CFP · captured after pupil dilation:
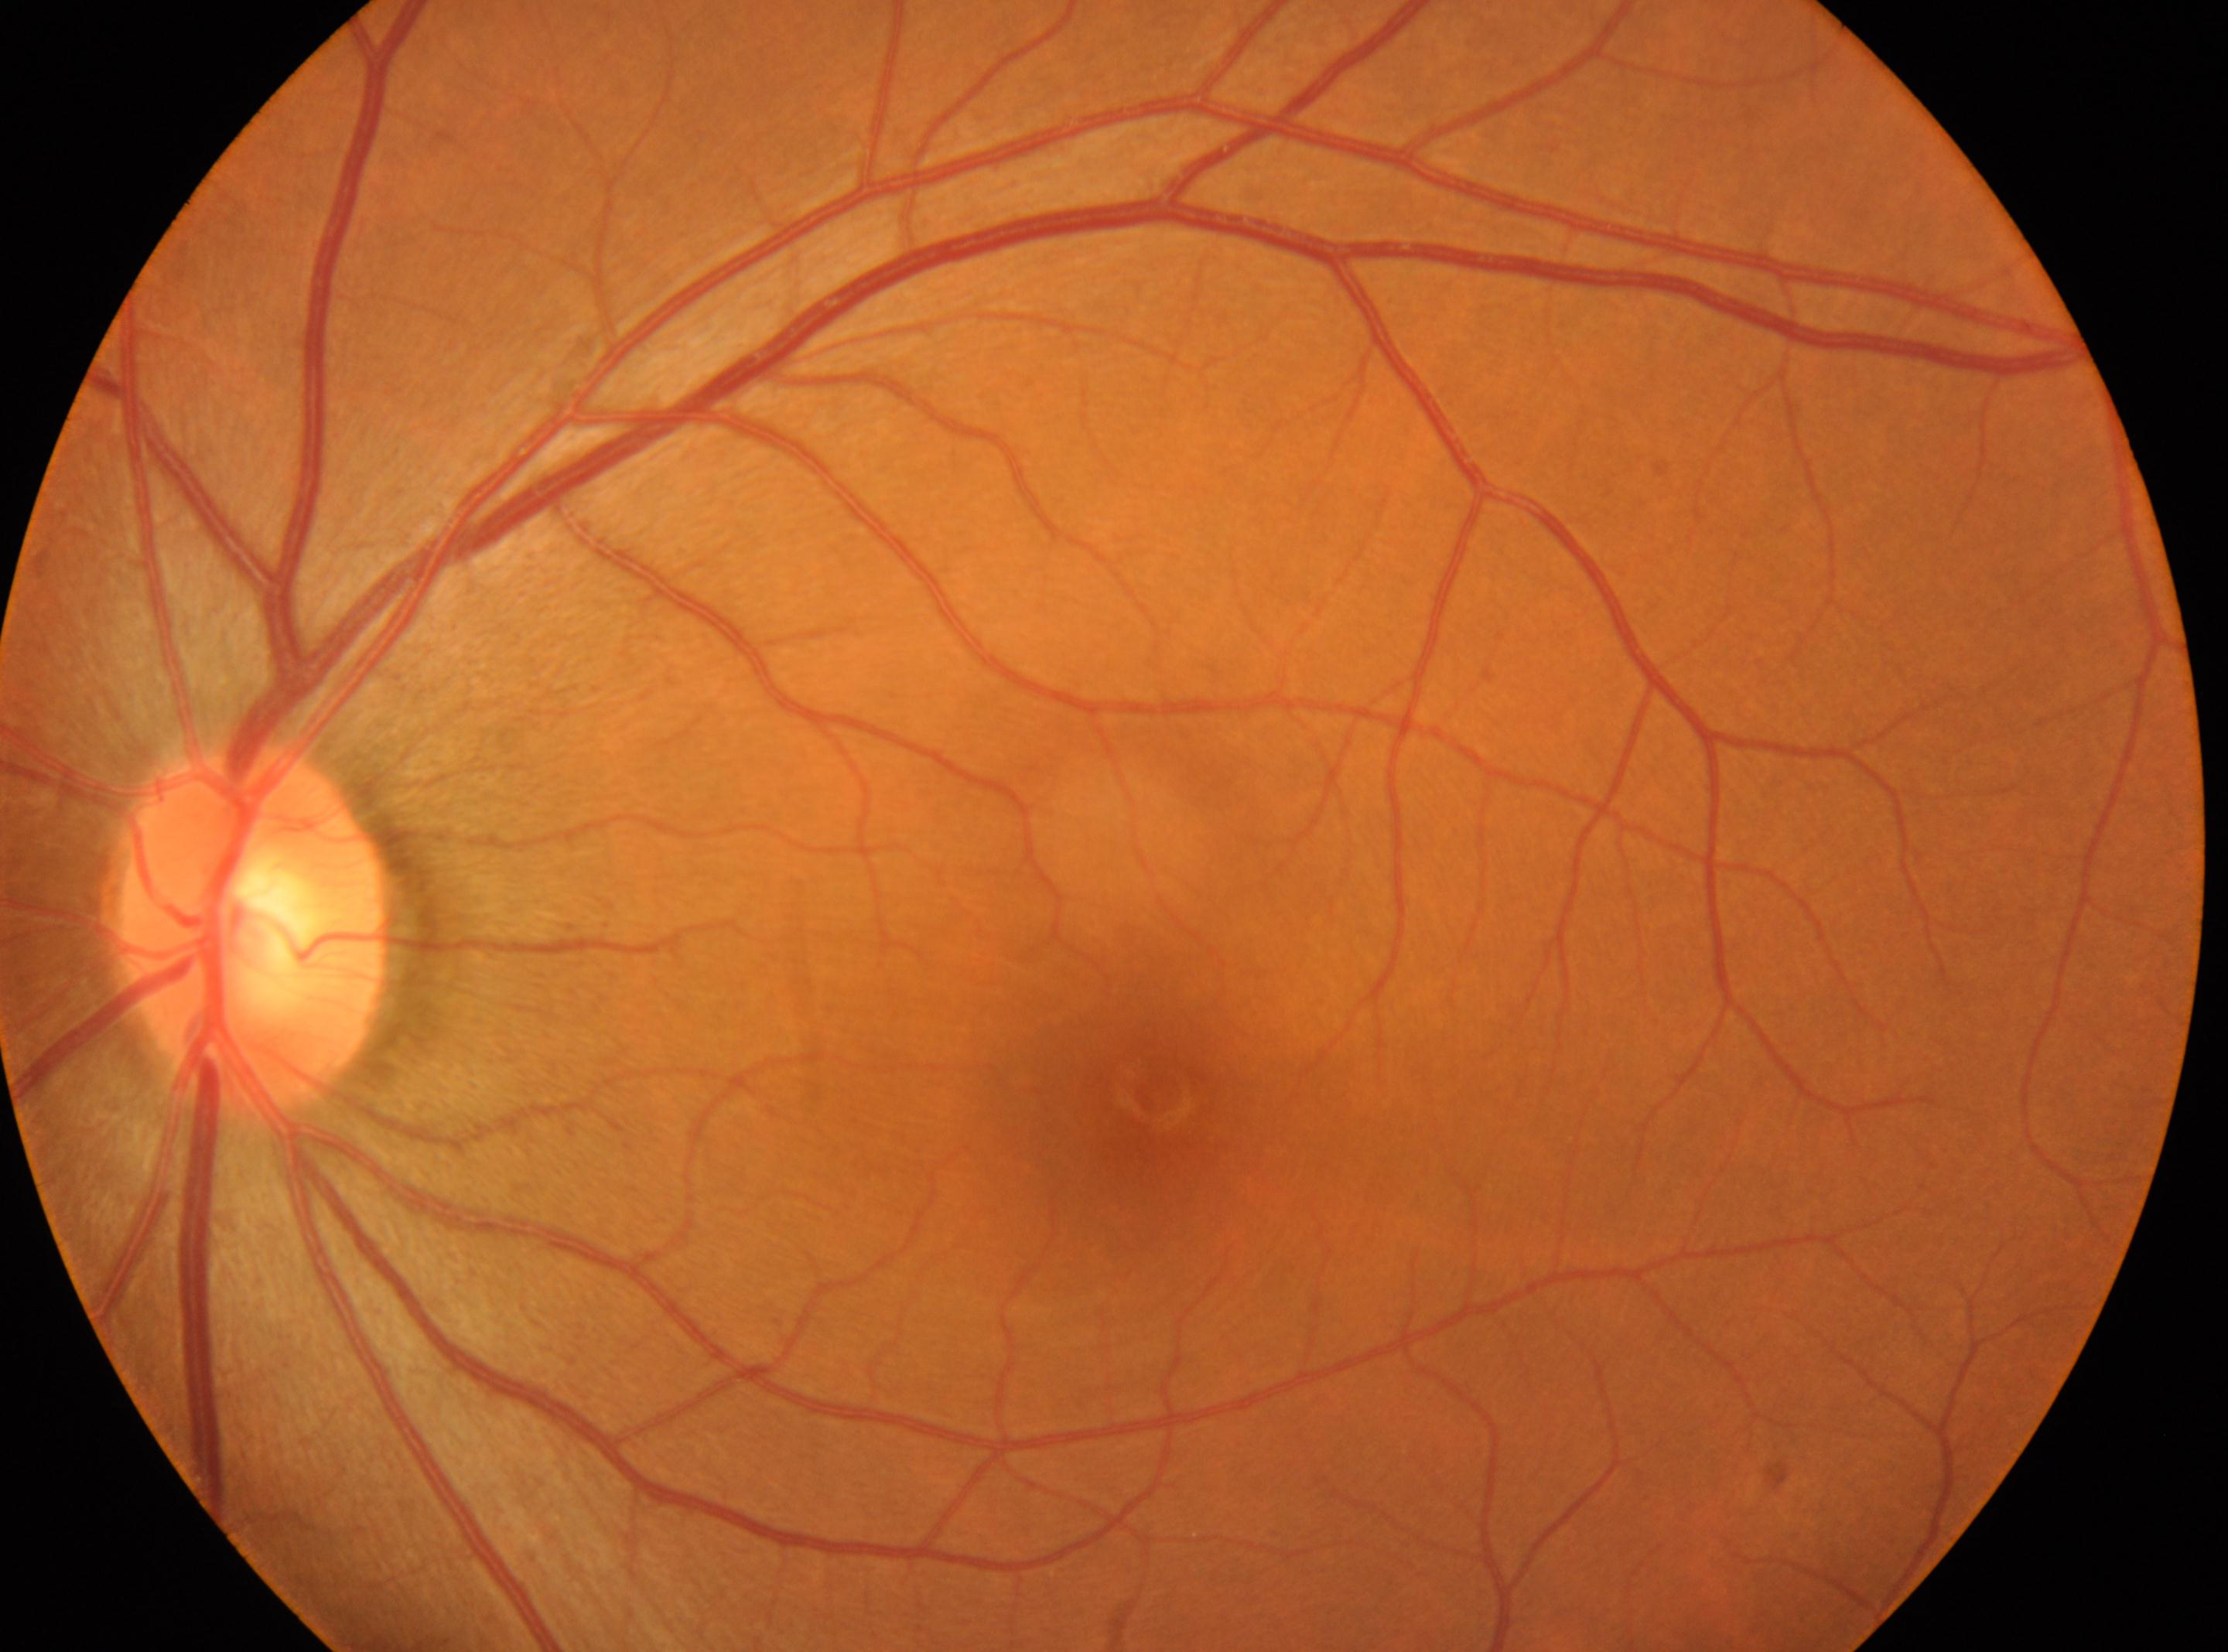 Optic disc located at (254, 929). No DR findings. Diabetic retinopathy (DR) is no apparent diabetic retinopathy (grade 0). Imaged eye: OS. Fovea center located at (1145, 1101).